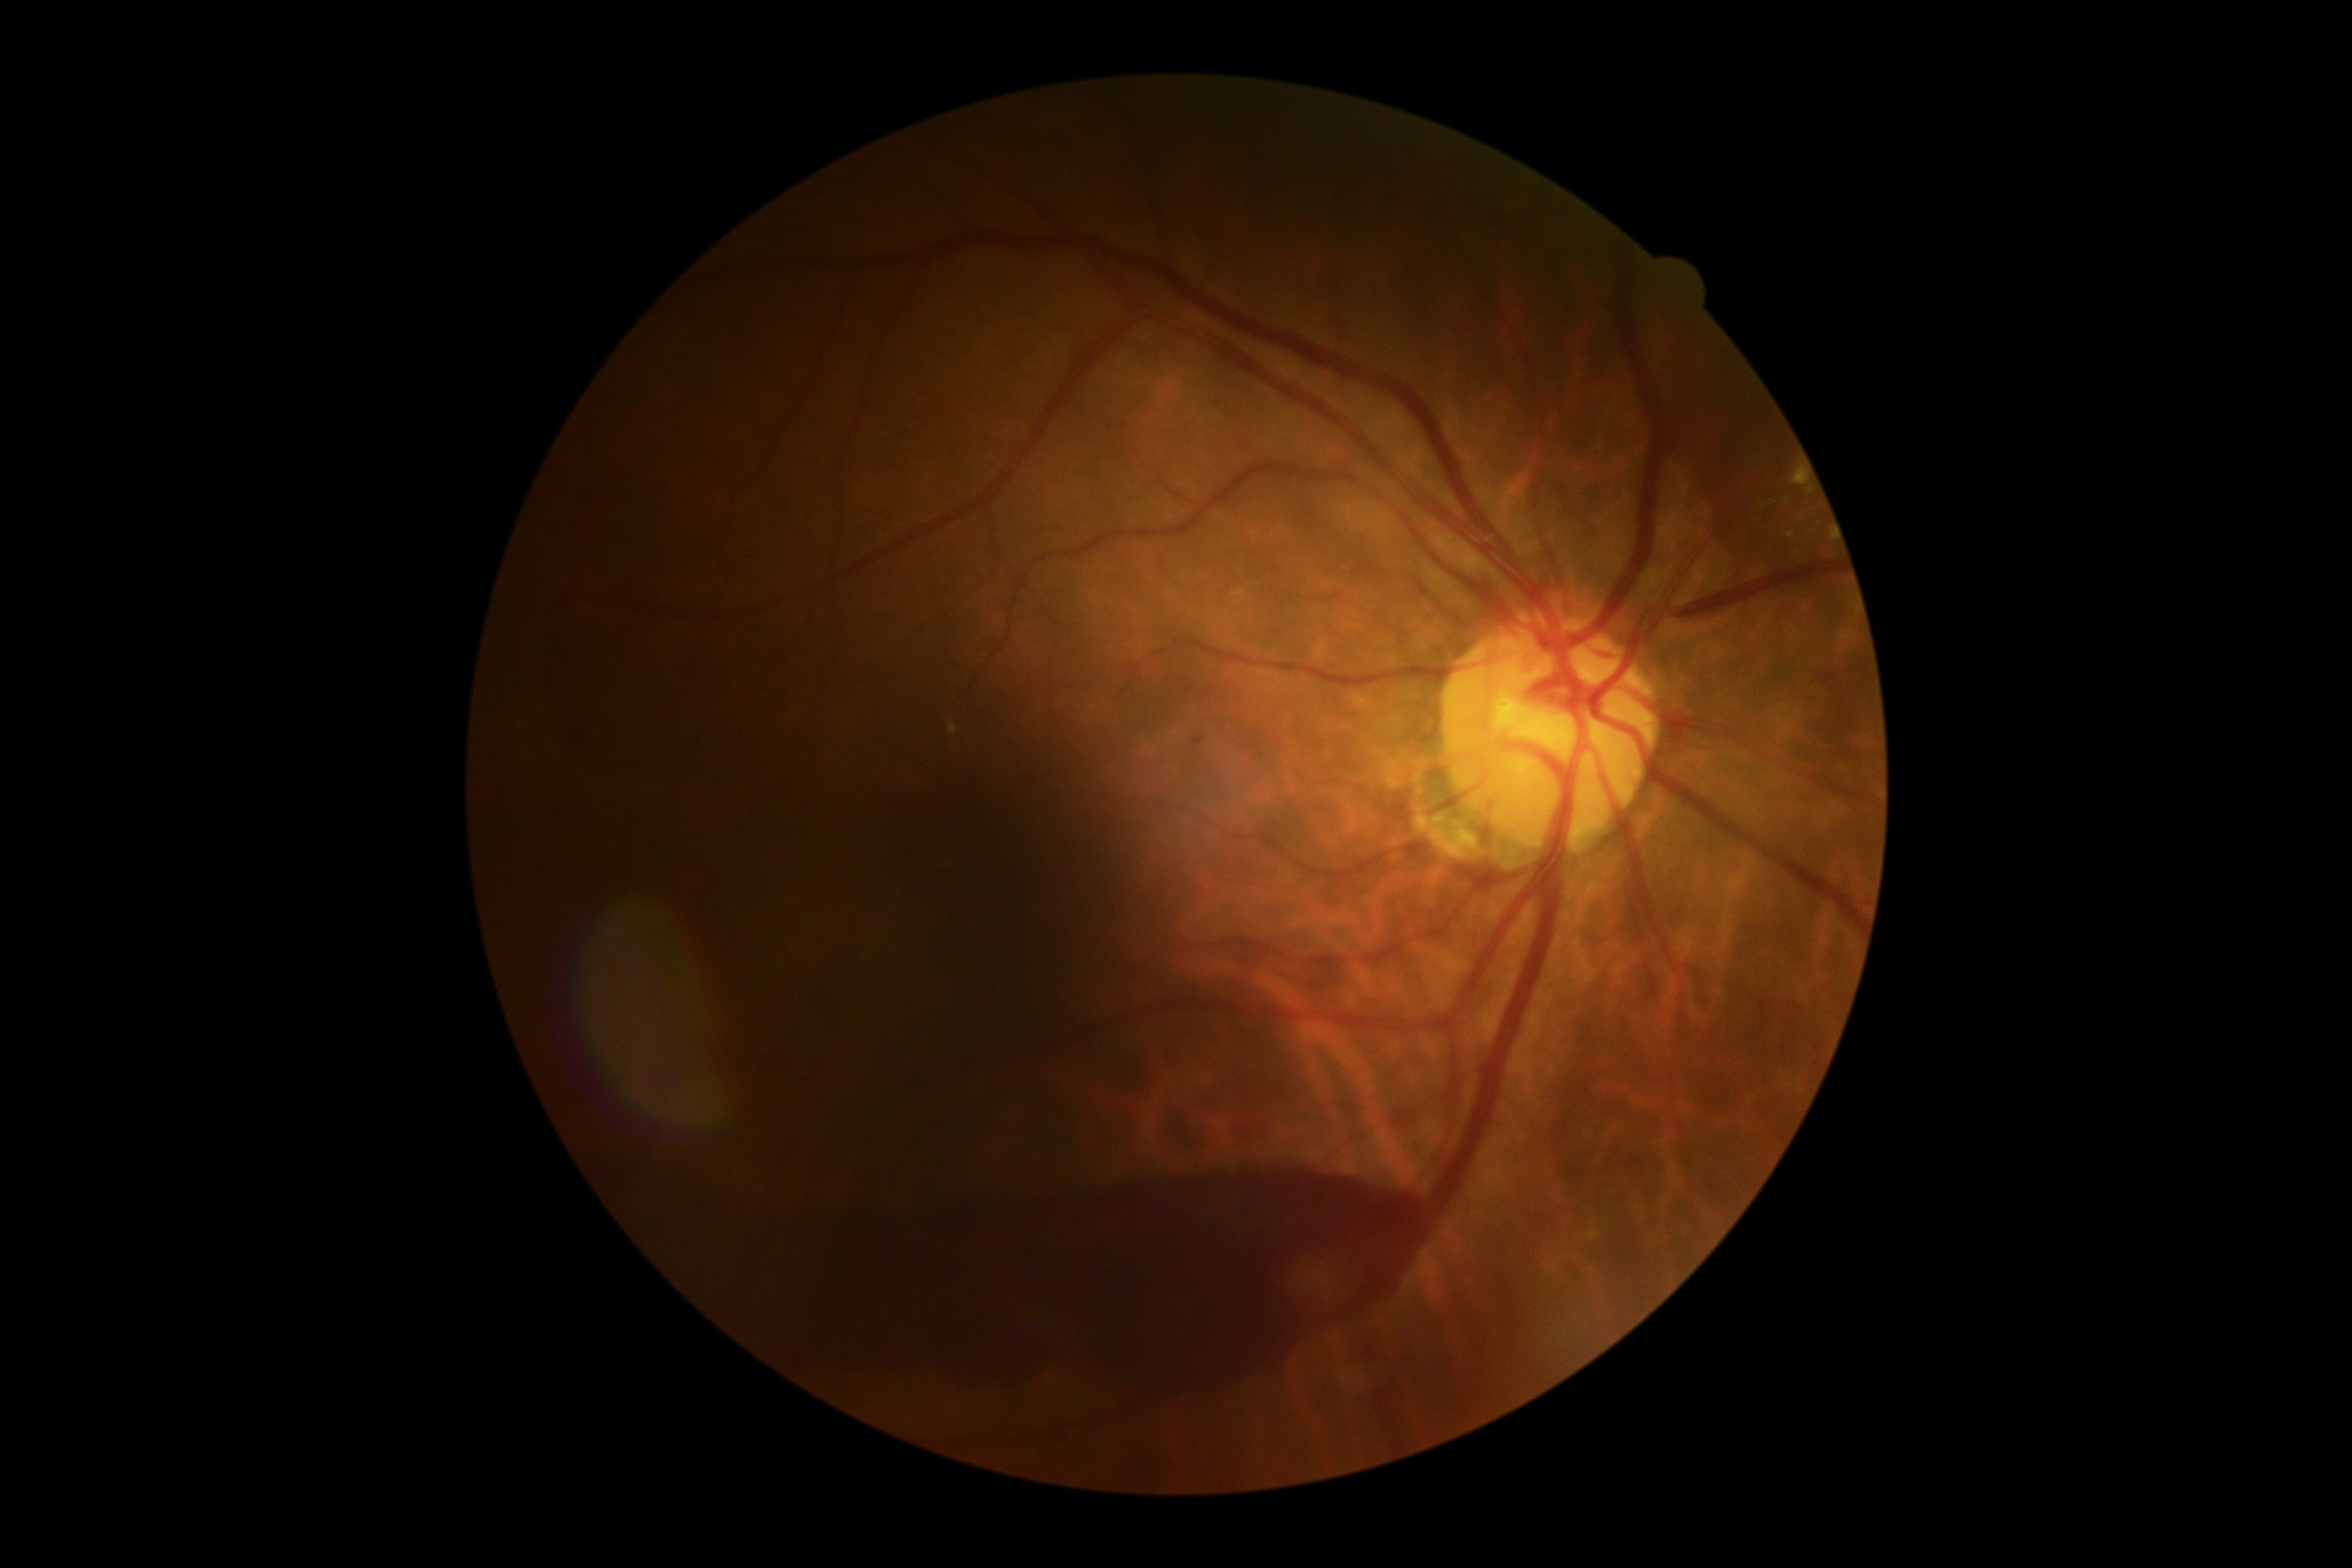
Diabetic retinopathy grade is 4/4.